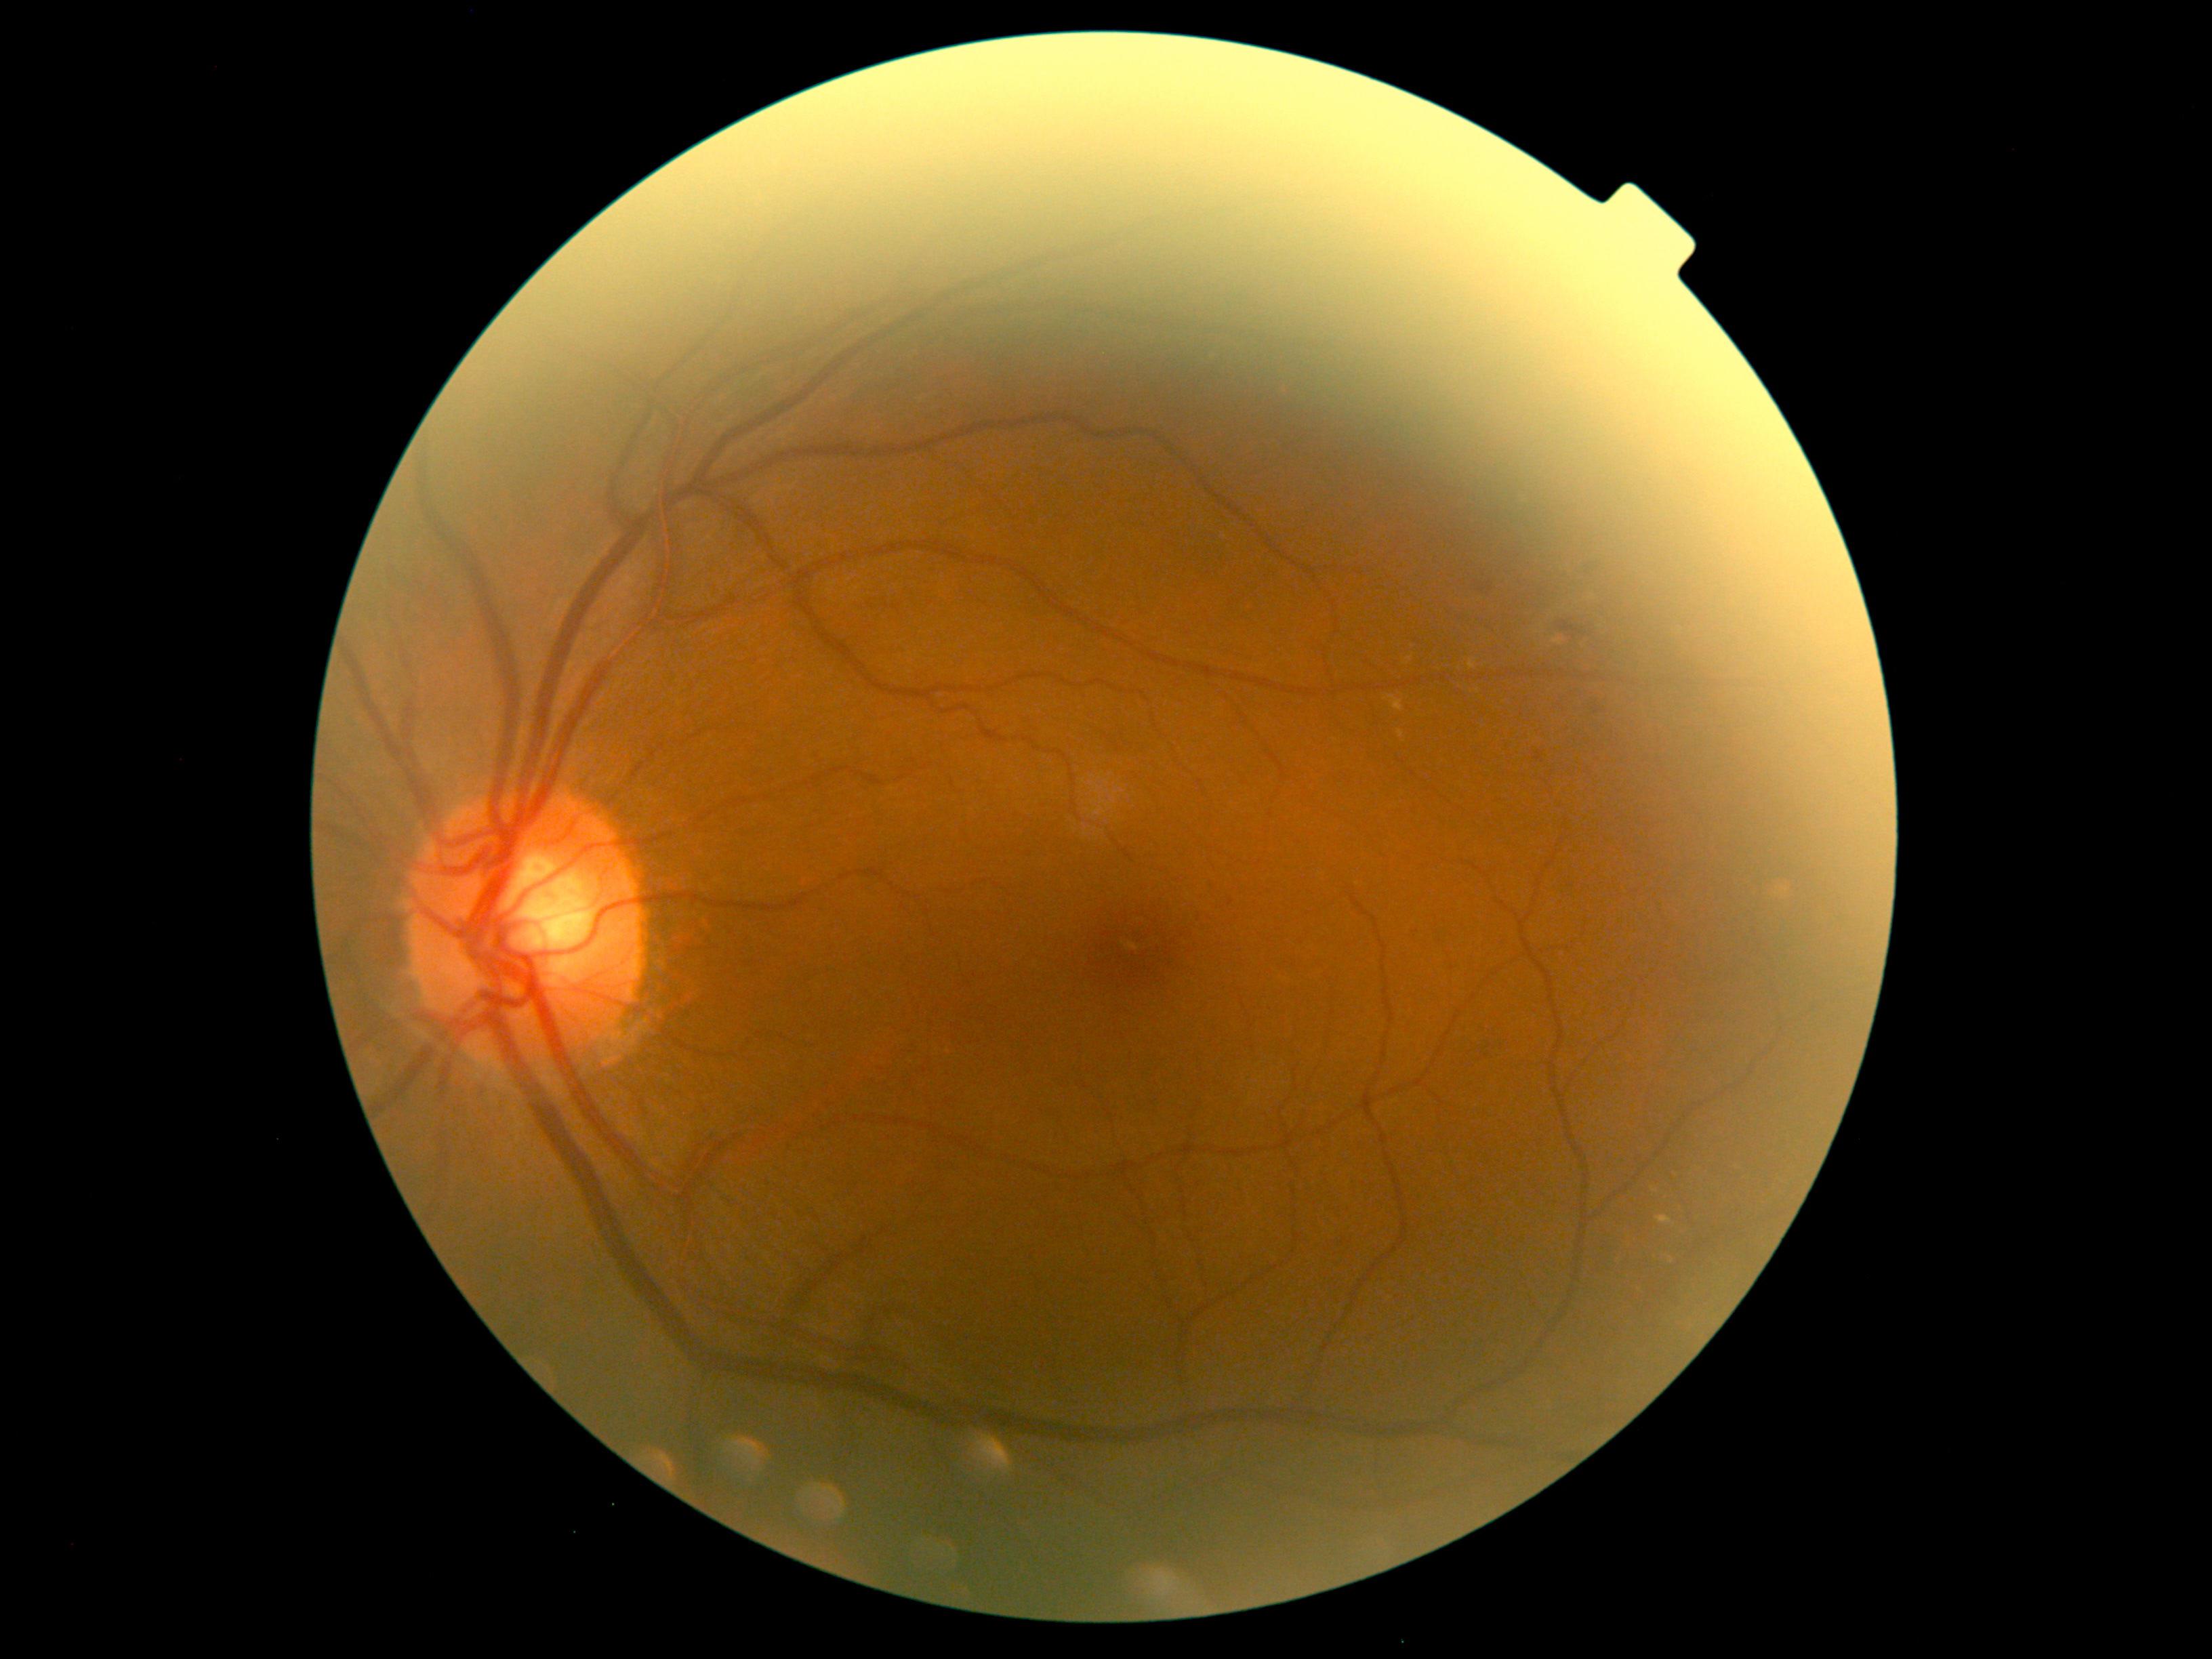 Diabetic retinopathy (DR): moderate non-proliferative diabetic retinopathy (grade 2).